Wide-field fundus image from infant ROP screening: 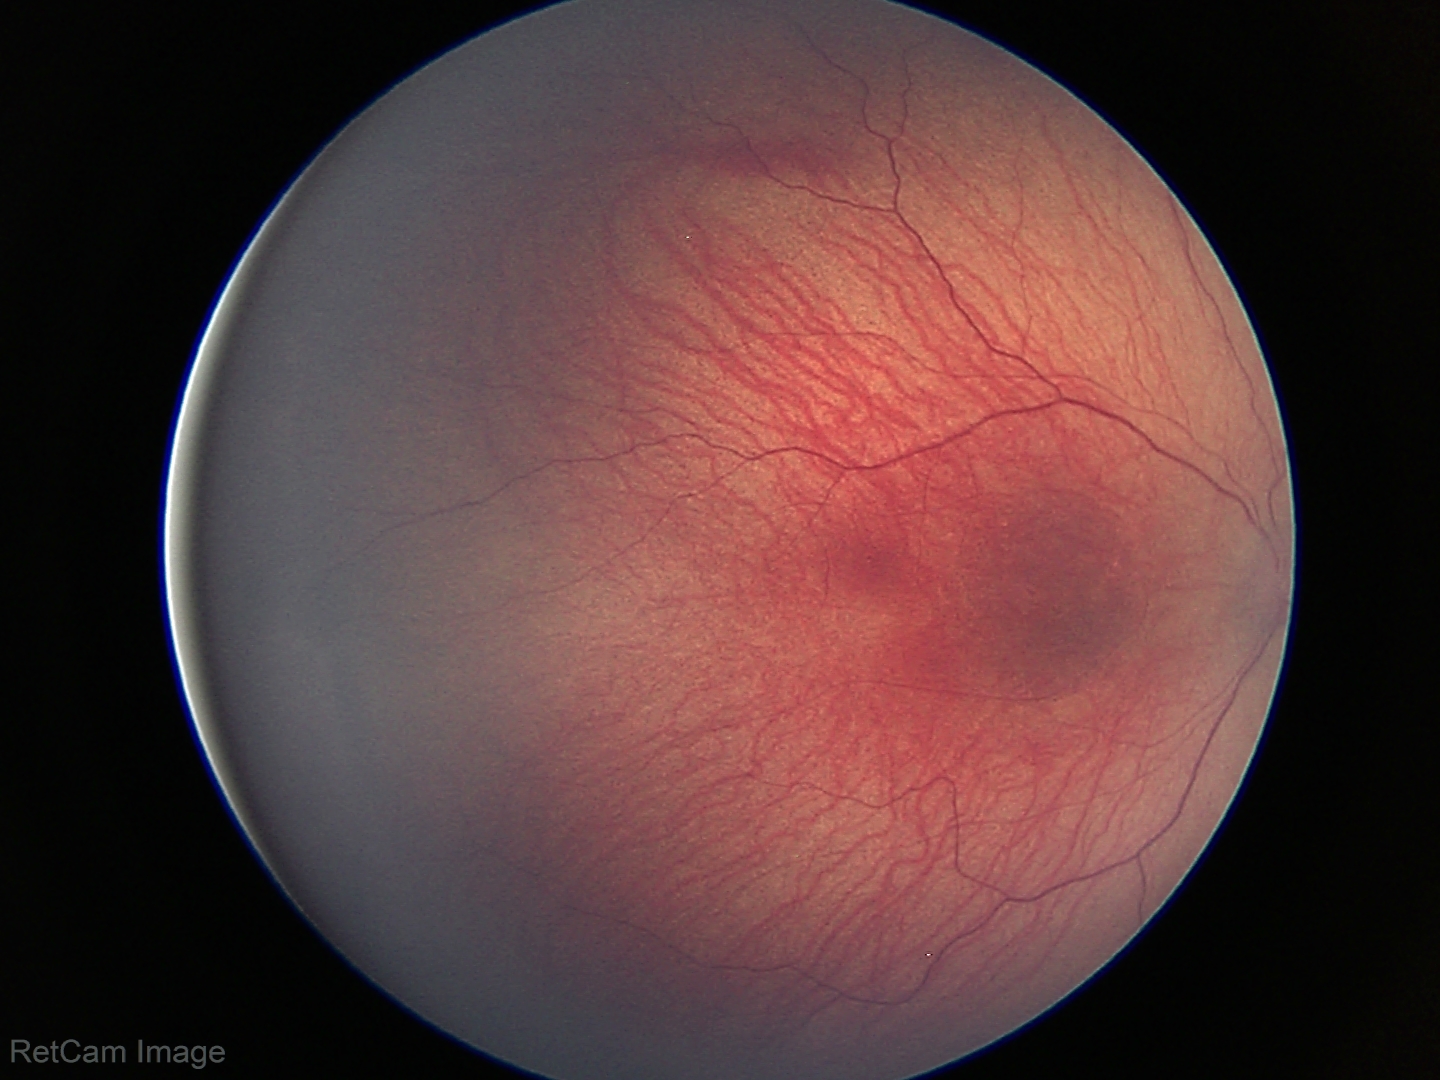

Q: Is plus disease present?
A: no plus disease
Q: What is the screening diagnosis?
A: ROP stage 1 — demarcation line between vascular and avascular retina